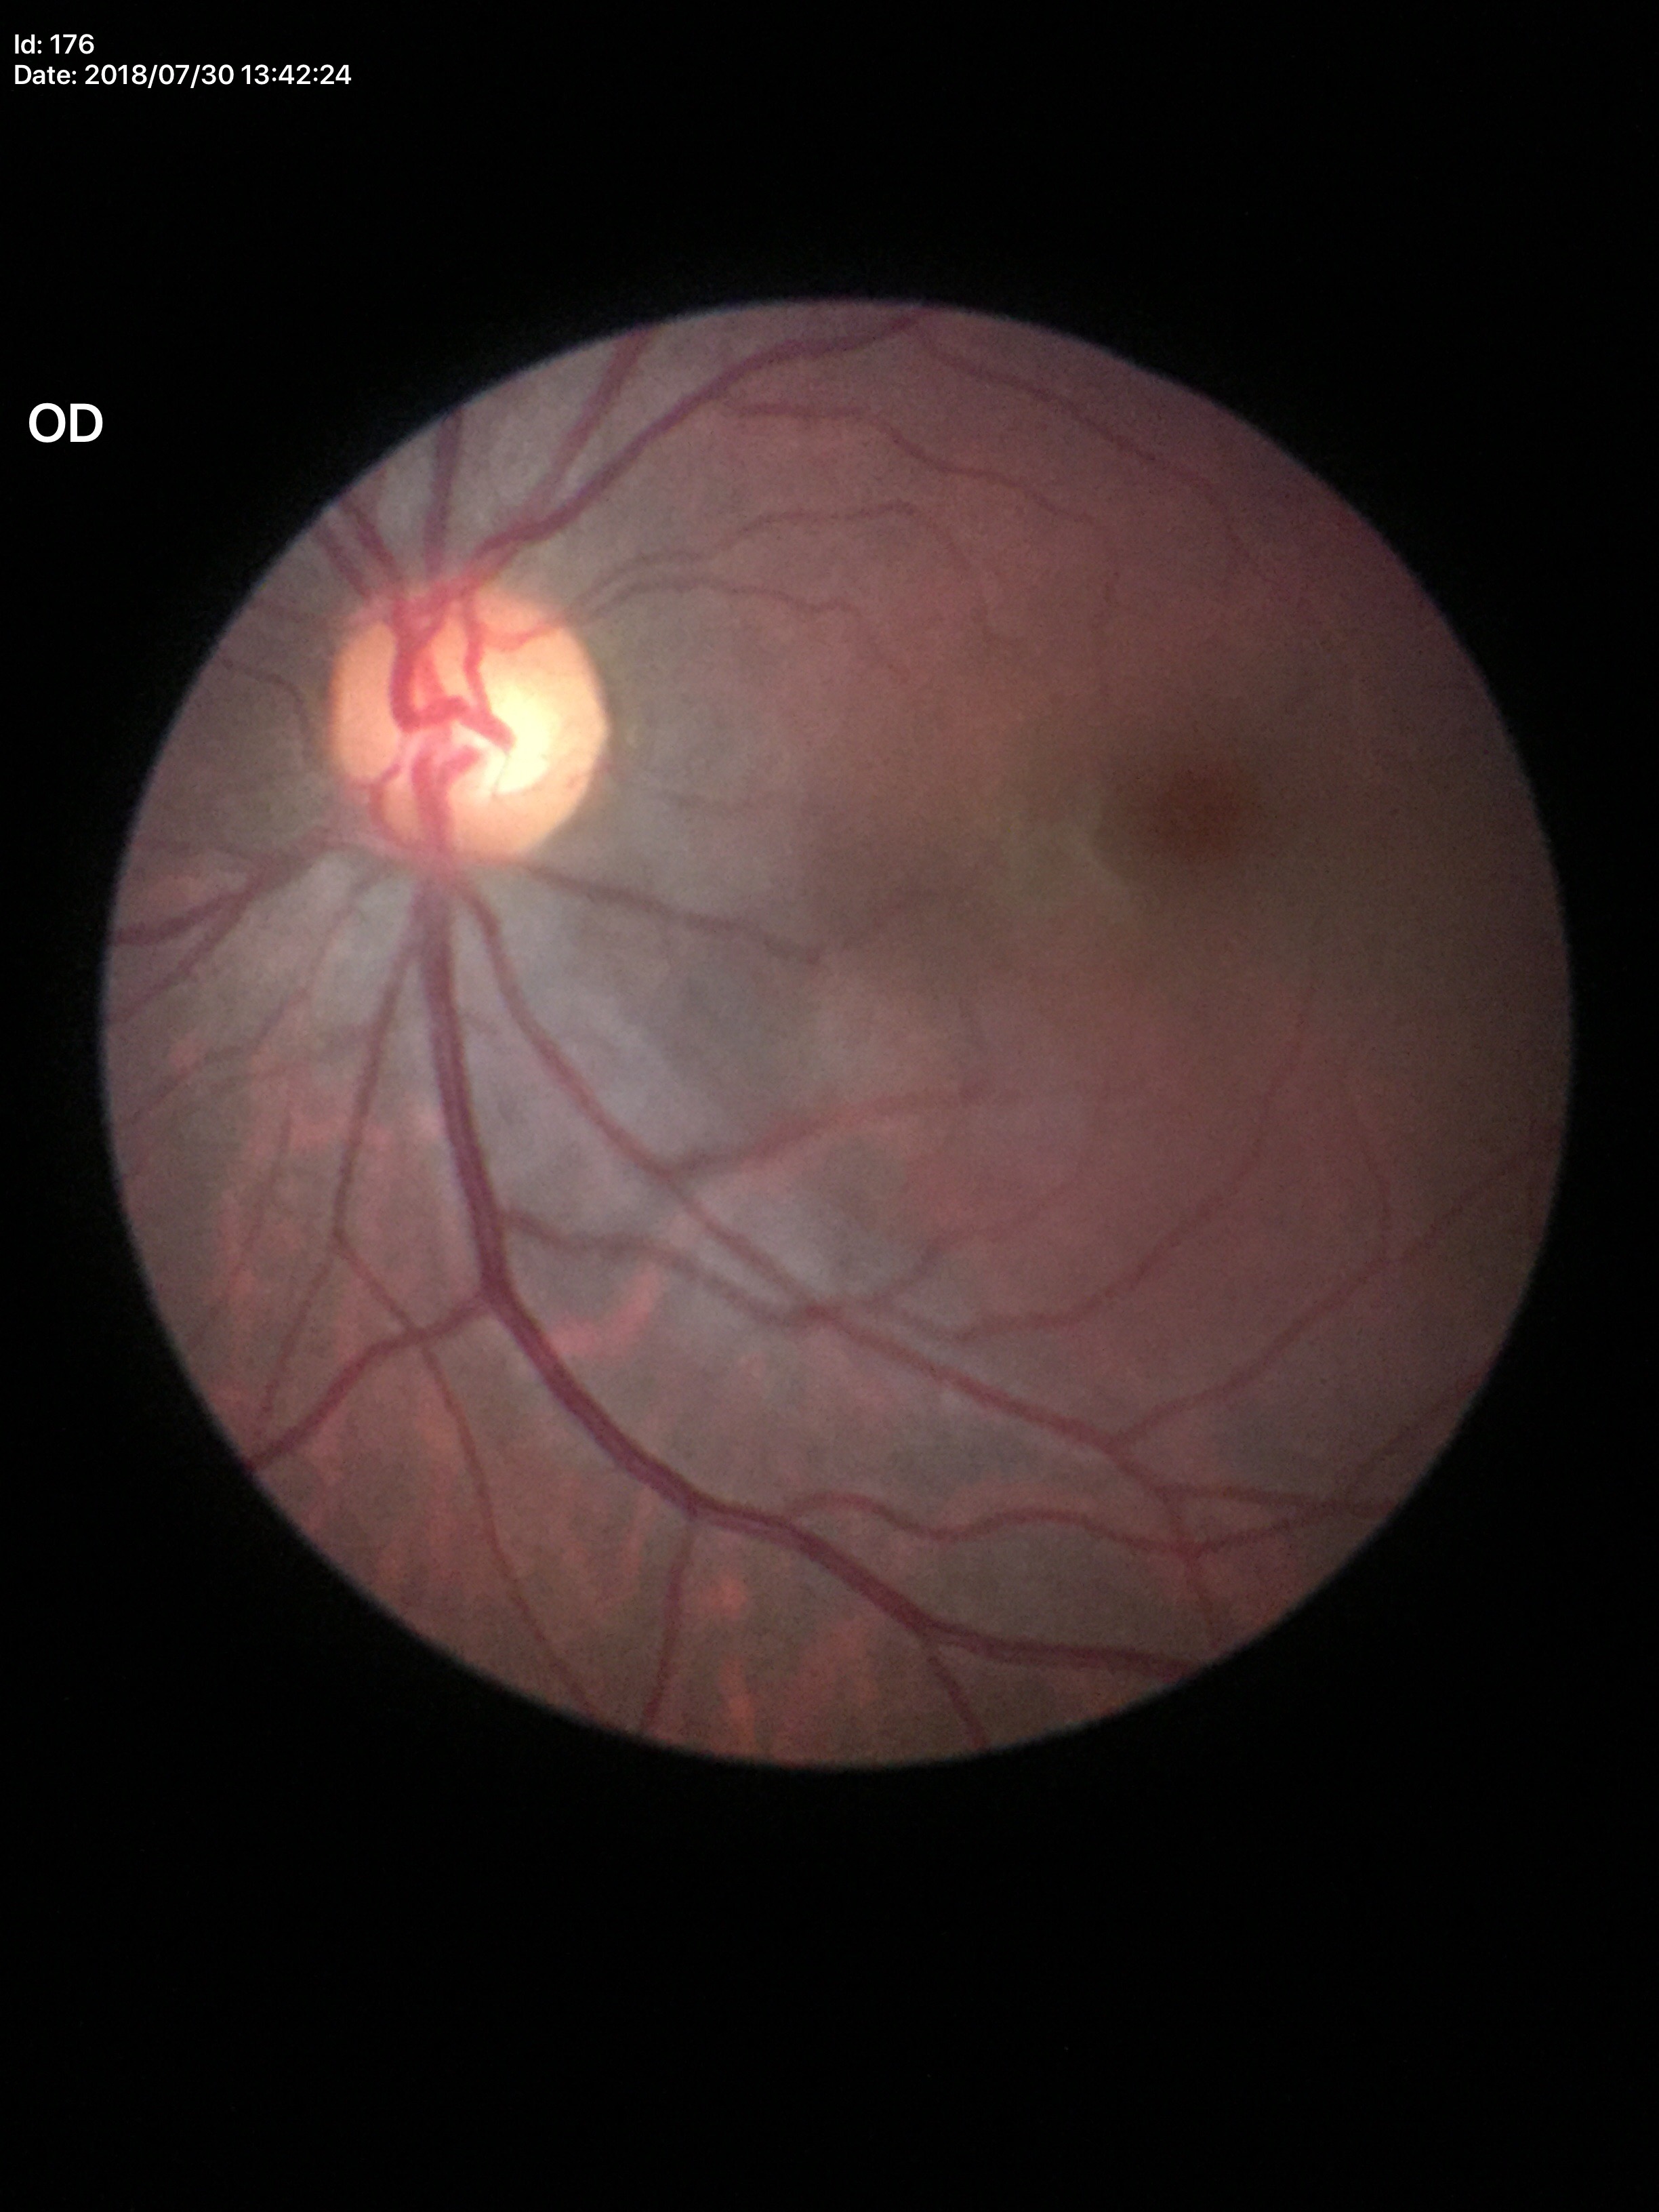
No evidence of glaucoma (2/5 graders called glaucoma suspect).
ACDR of 0.33.
VCDR: 0.56.